Acquired on the Phoenix ICON · wide-field contact fundus photograph of an infant.
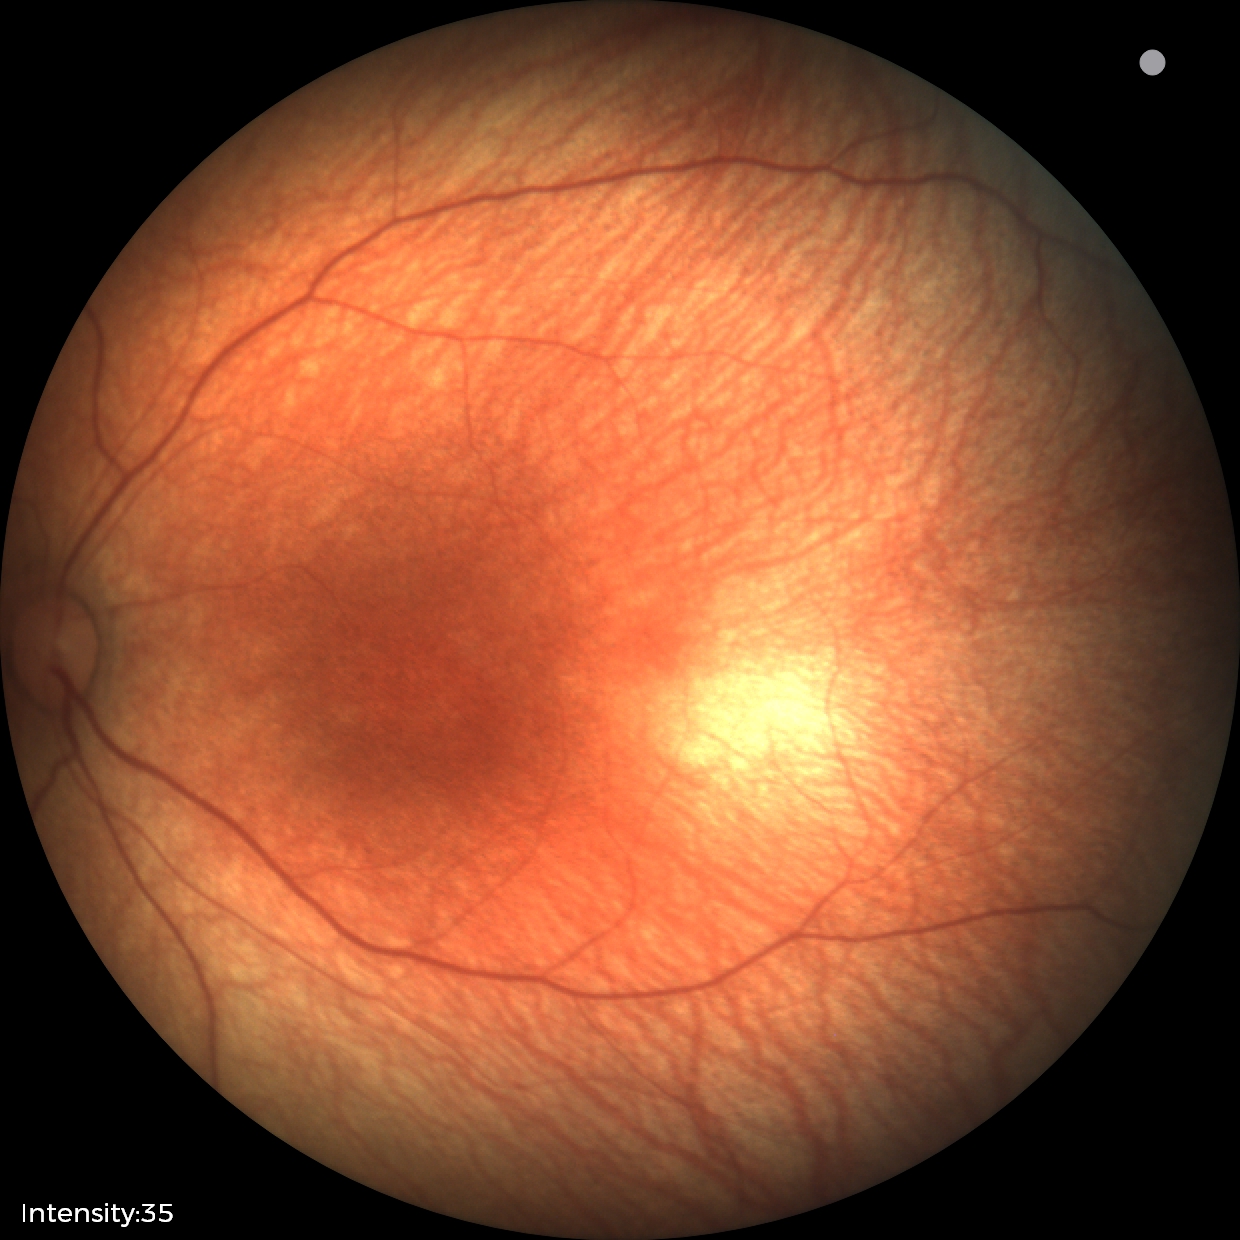

Impression: physiological finding.